CFP, image size 2228x1652, camera: Topcon TRC-50DX, dilated-pupil acquisition, 50° field of view, field includes the optic disc and macula.
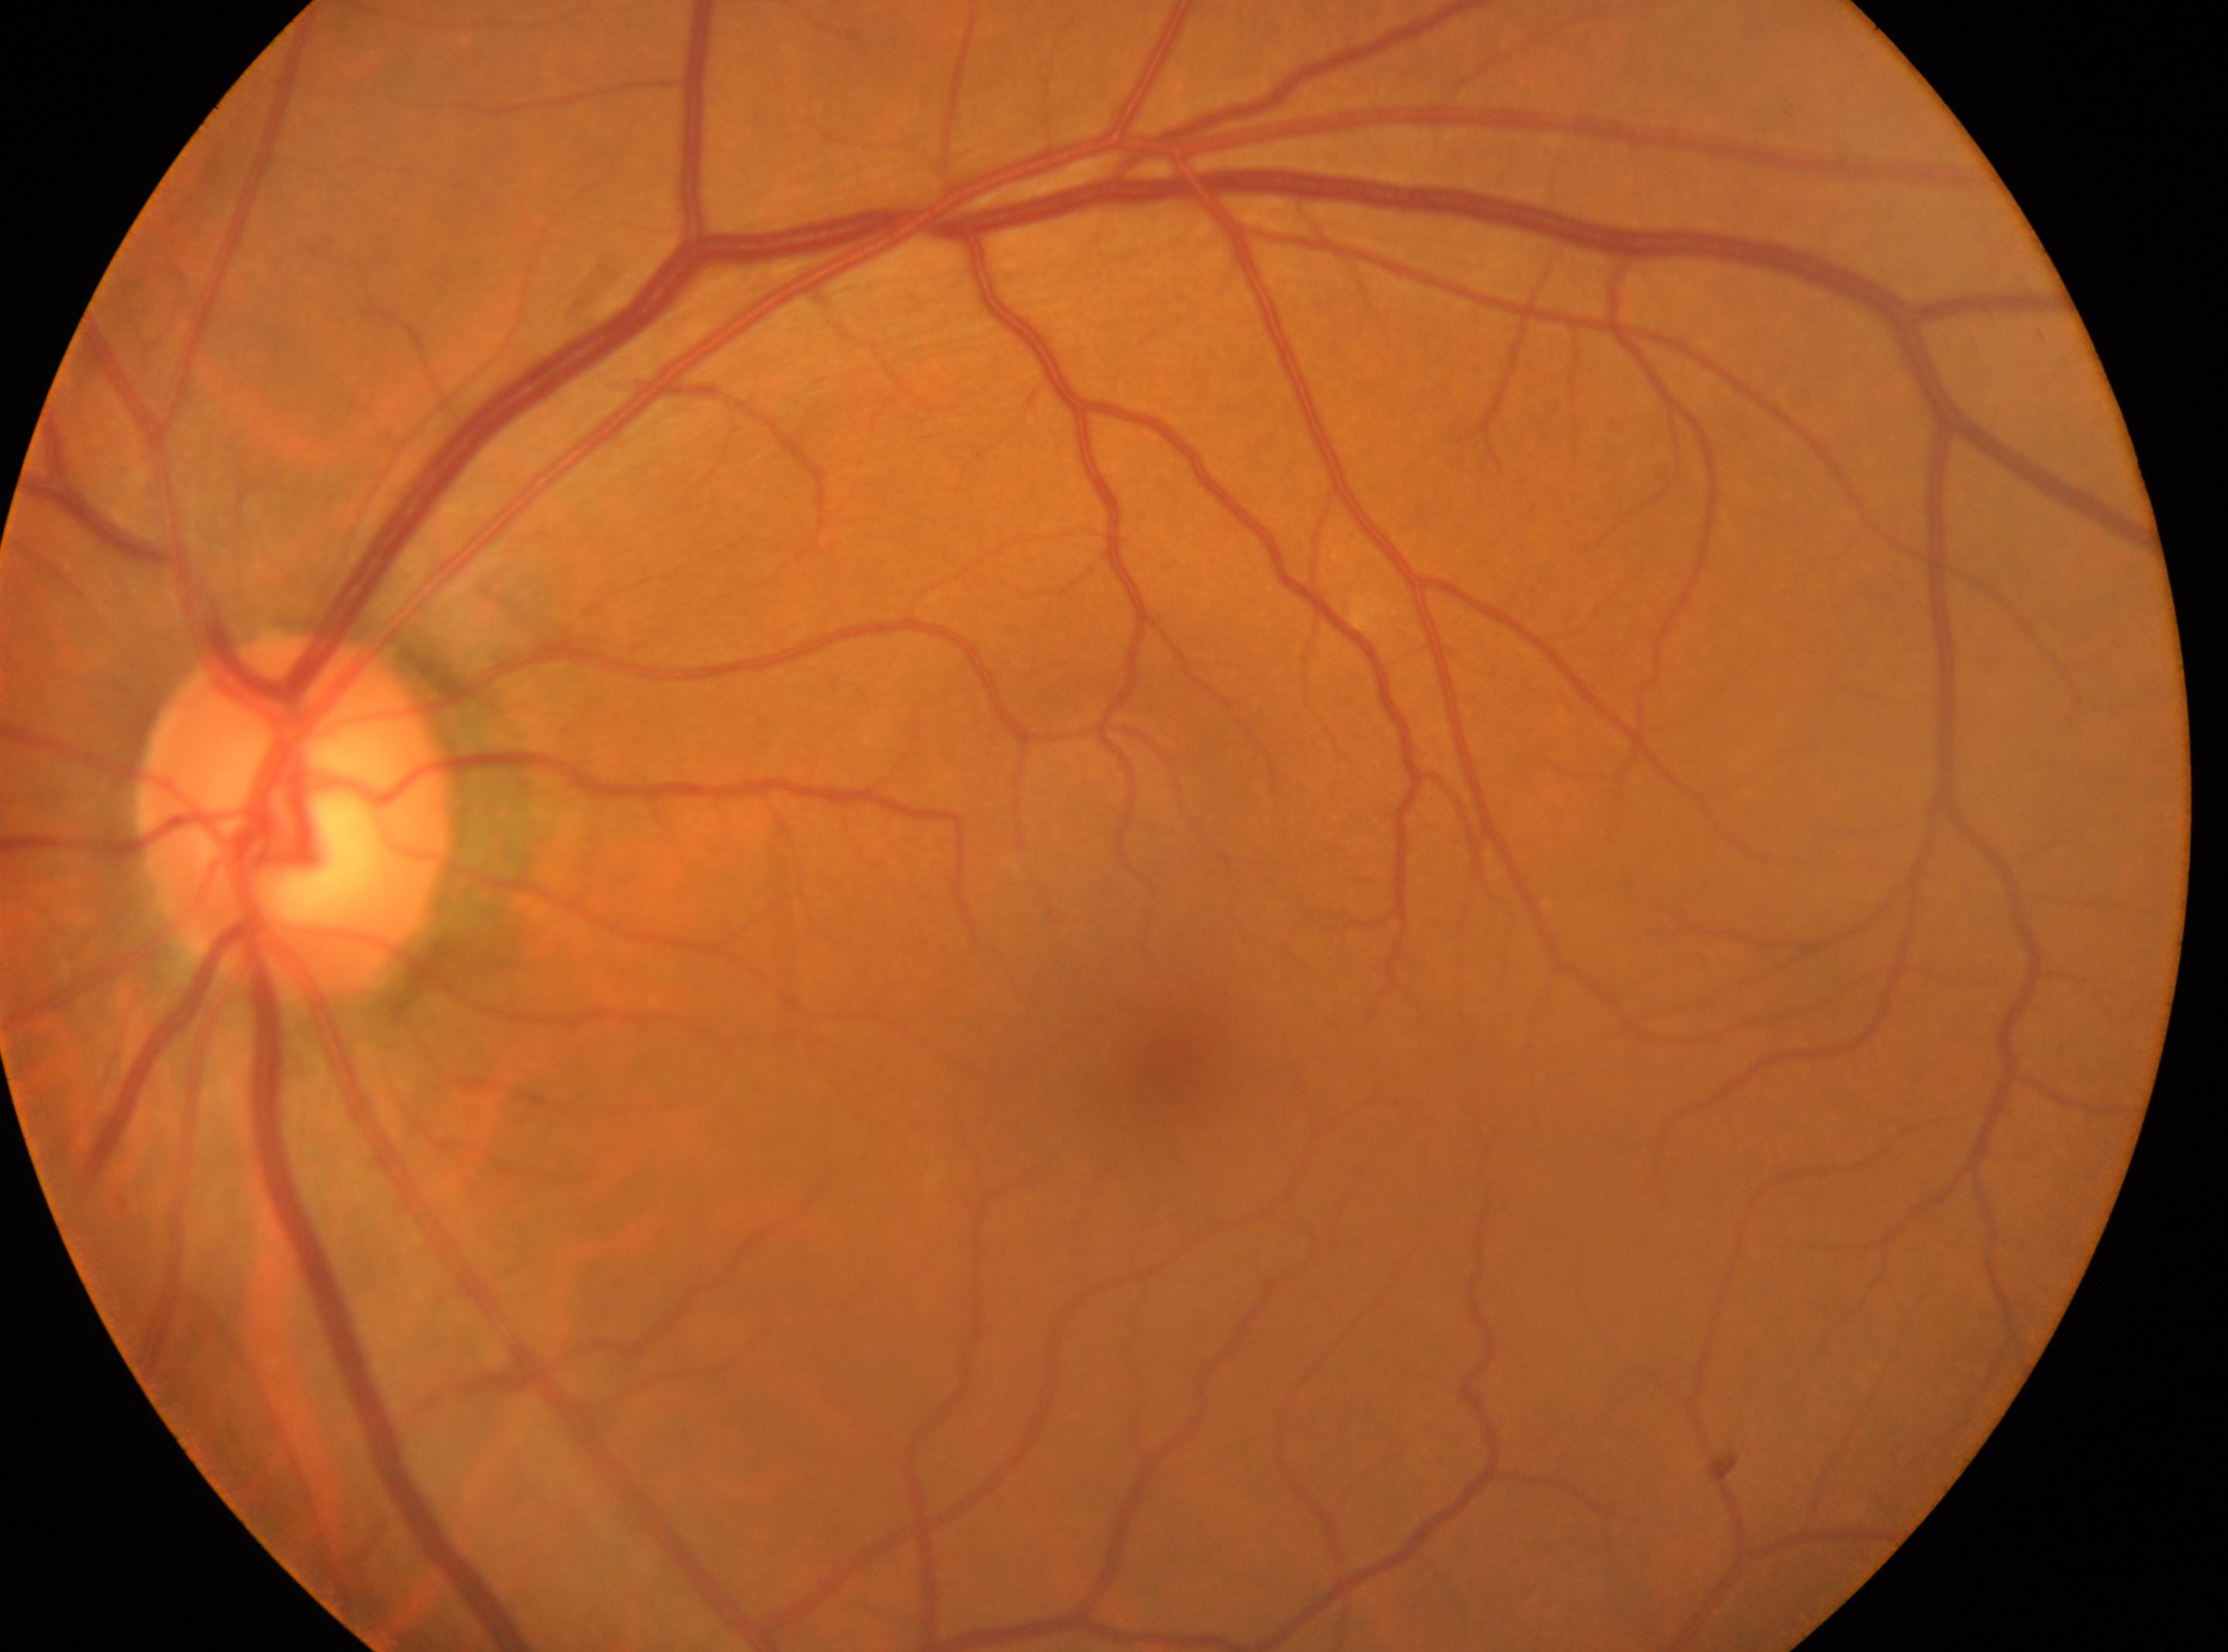
optic disc center: (x: 299, y: 815), laterality: left eye, diabetic retinopathy (DR): grade 0 (no apparent retinopathy), foveal center: (x: 1160, y: 1070).